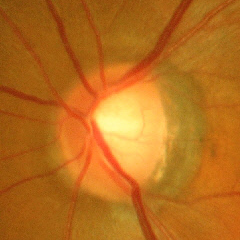
Glaucoma assessment = advanced-stage glaucoma.